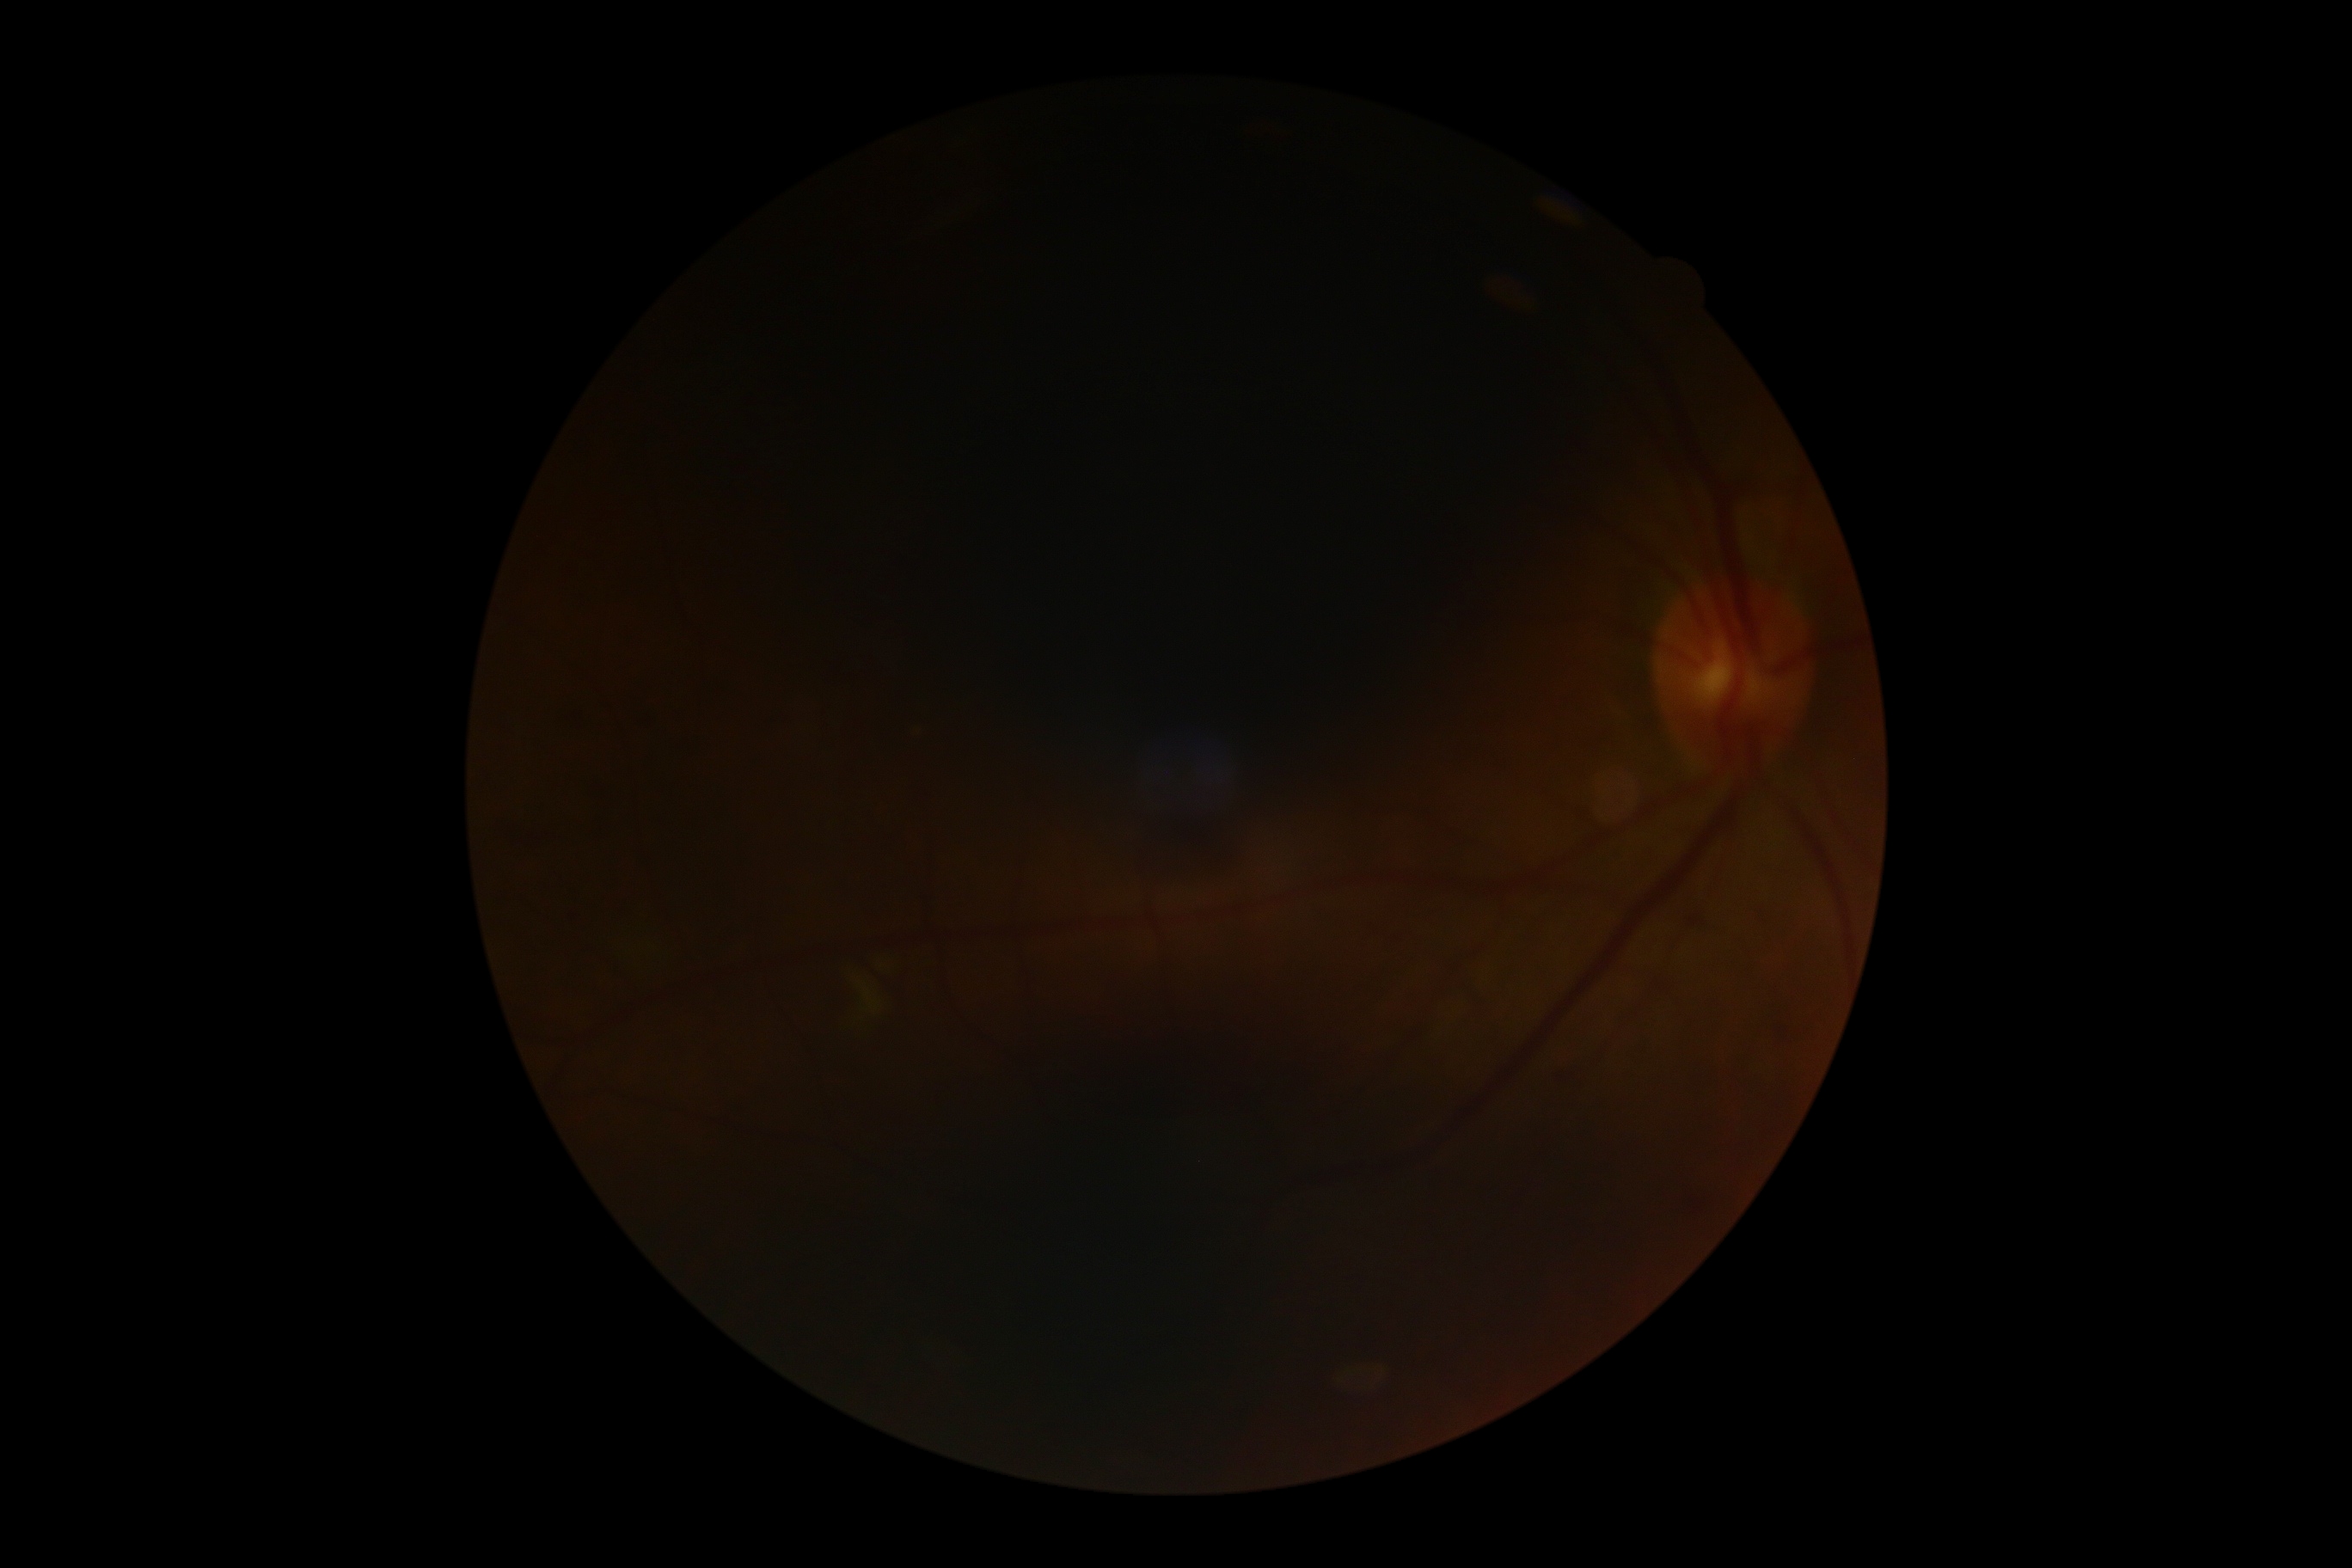 DR severity = ungradable due to poor image quality.